50° field of view; image size 1924x1556.
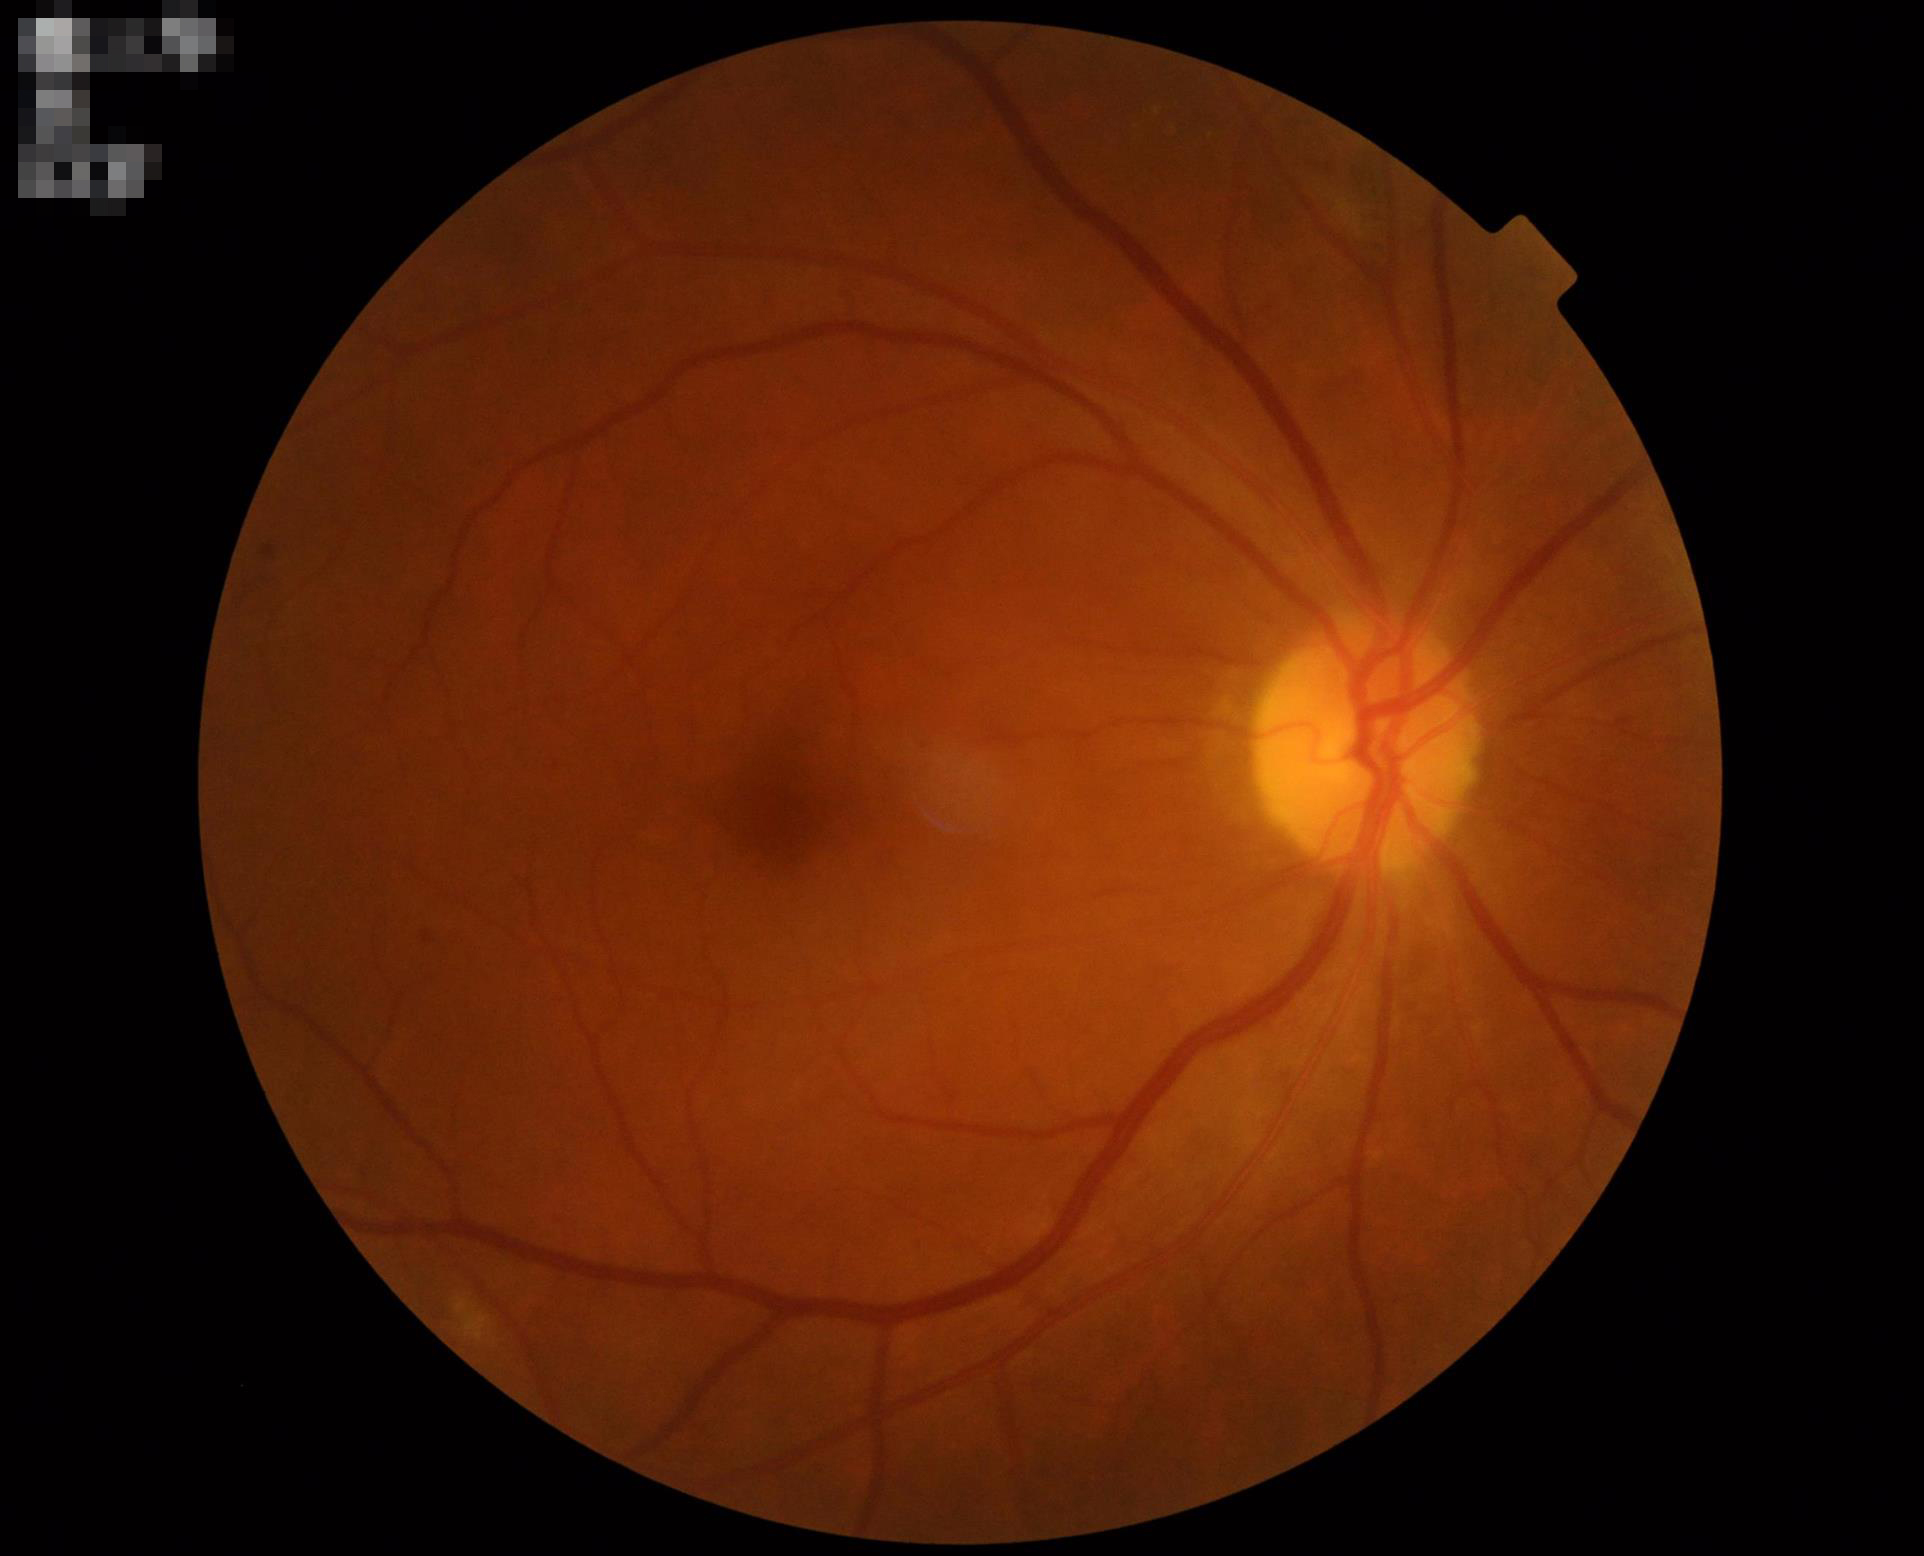 Quality assessment: illumination/color: adequate | focus: in focus | contrast: good | overall: satisfactory.